No pharmacologic dilation.
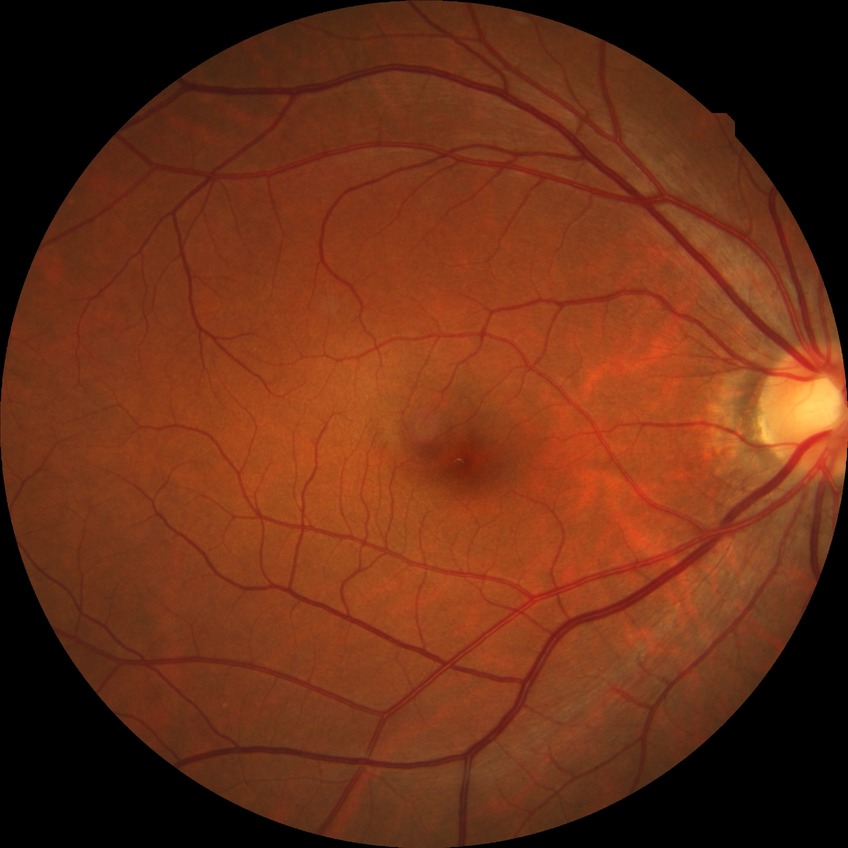 {"davis_grade": "no diabetic retinopathy"}